Without pupil dilation. Camera: NIDEK AFC-230. 848 x 848 pixels.
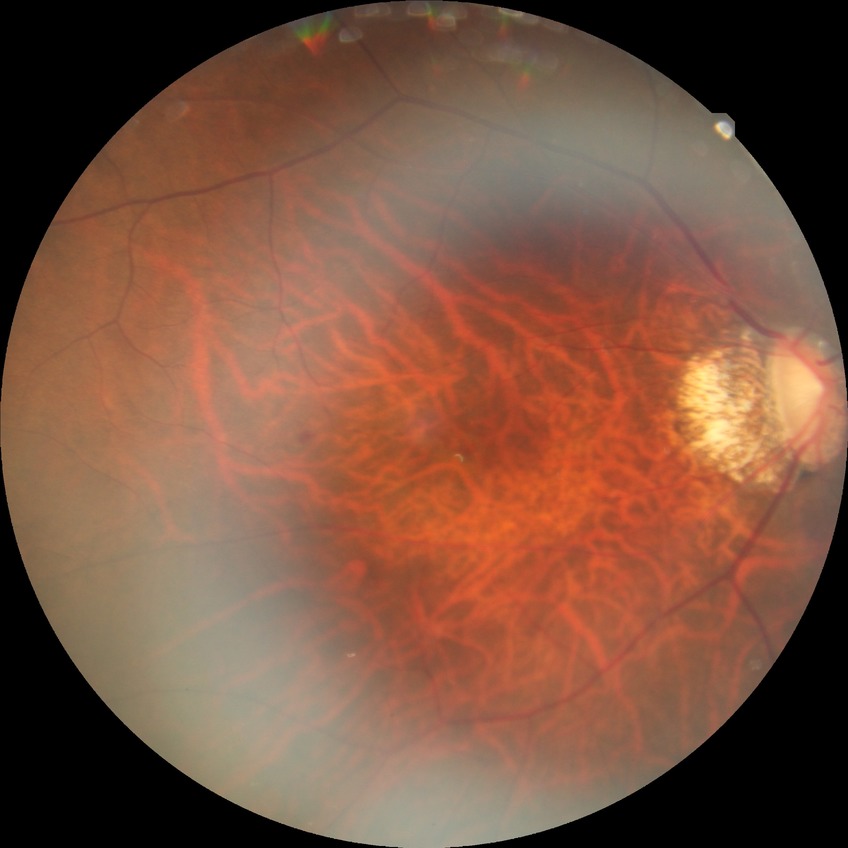 diabetic retinopathy stage@no diabetic retinopathy.